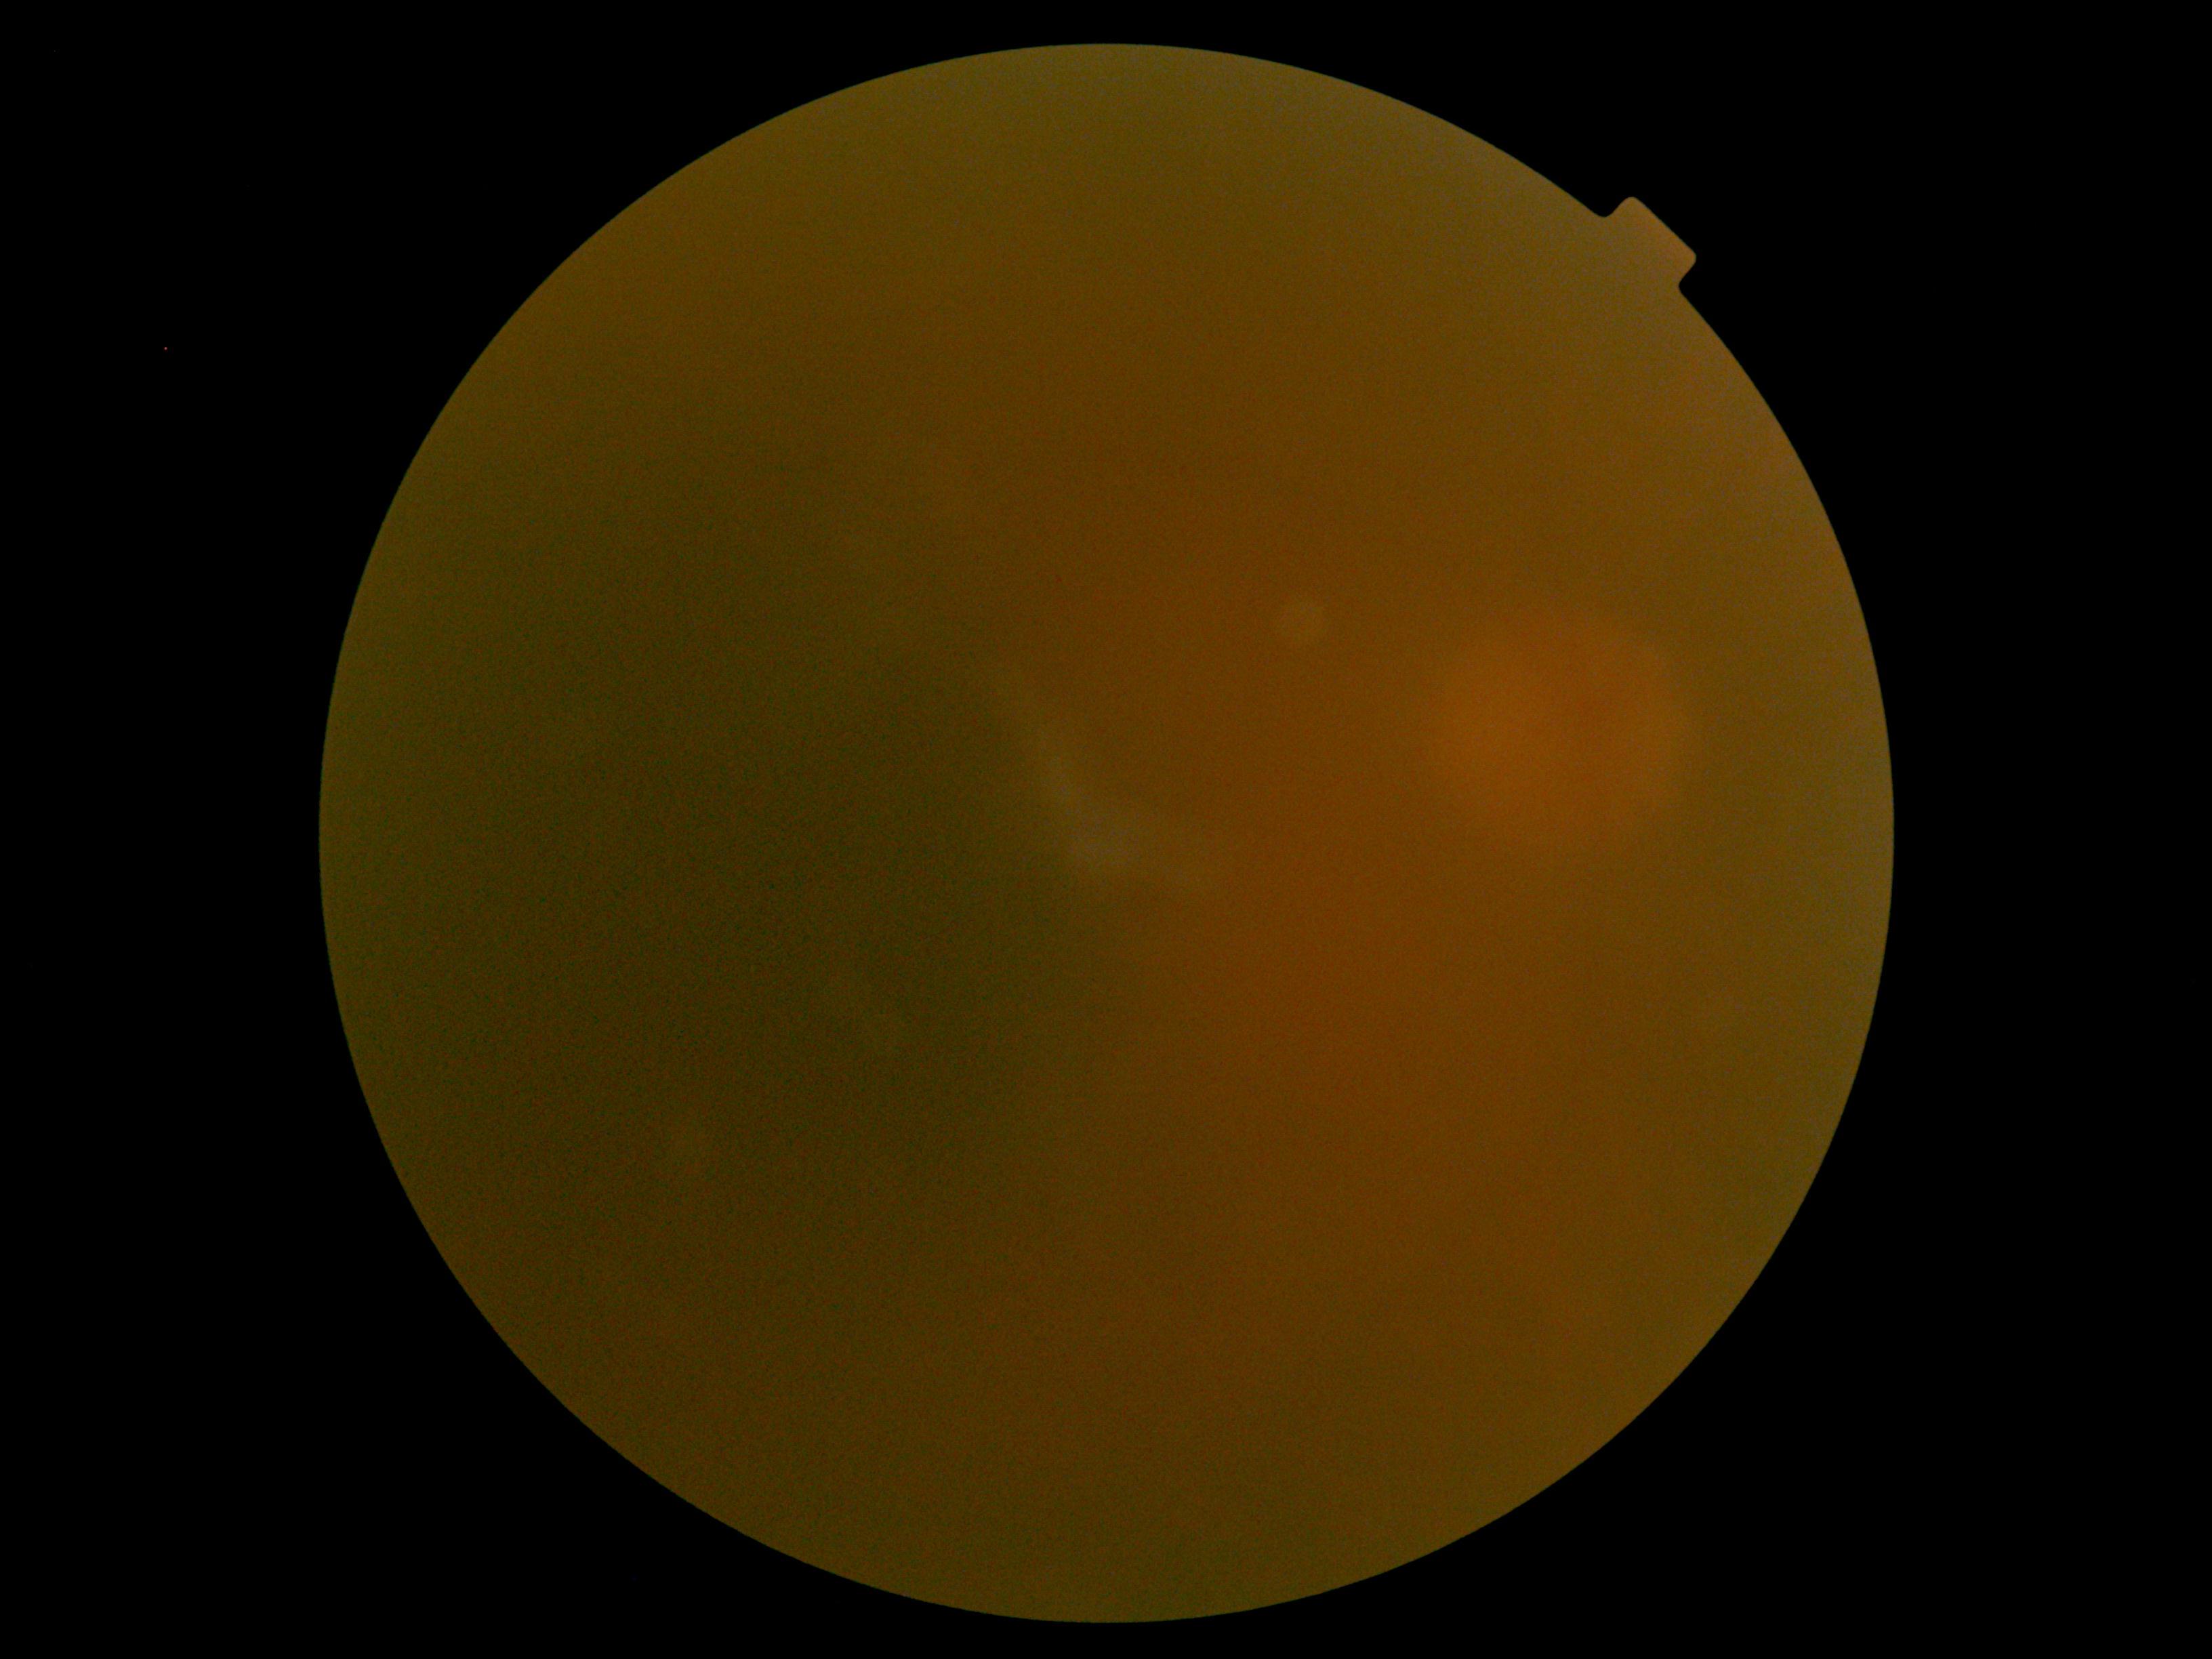
Findings:
* diabetic retinopathy (DR): ungradable